No pharmacologic dilation, diabetic retinopathy graded by the modified Davis classification, 848x848px, NIDEK AFC-230, posterior pole color fundus photograph, 45° FOV
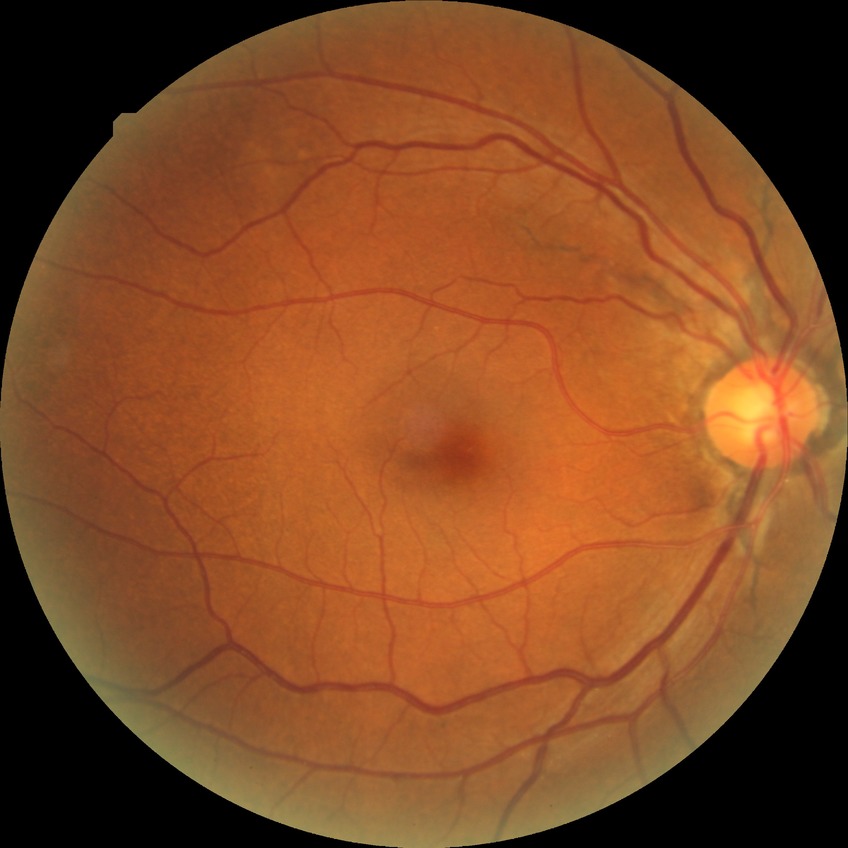

Modified Davis classification is no diabetic retinopathy.